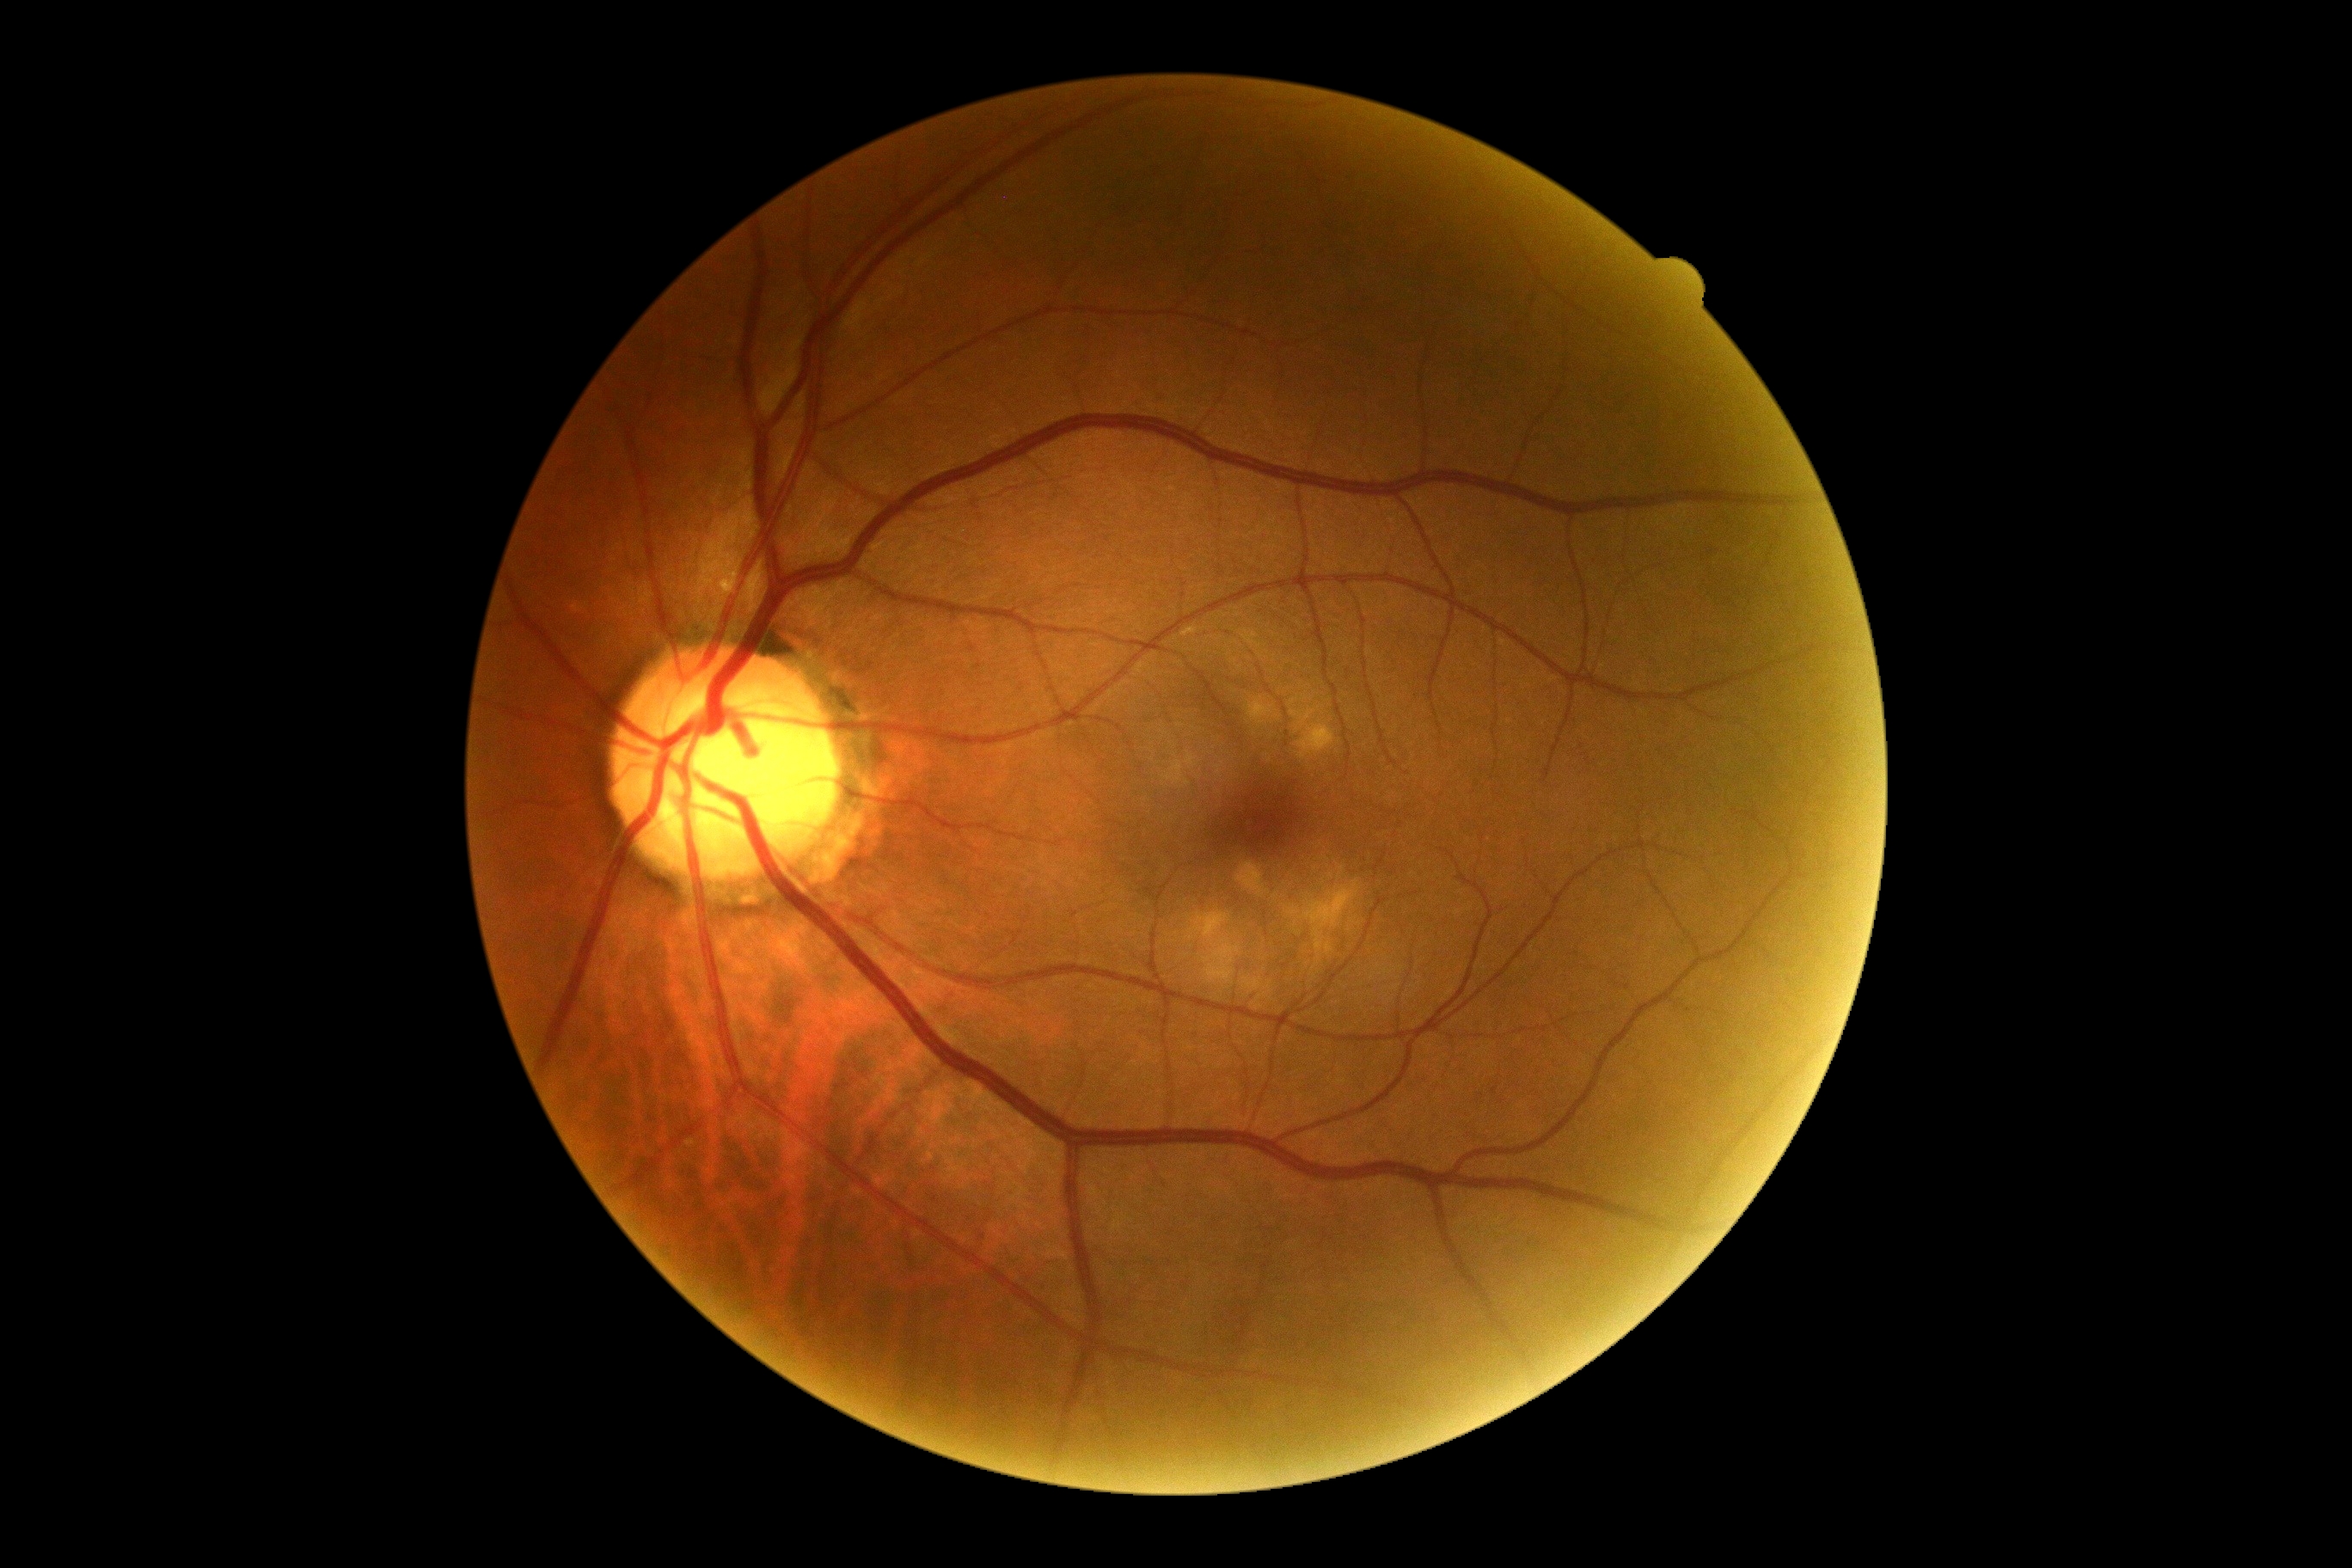

DR stage: no apparent retinopathy (grade 0).